Wide-field fundus image from infant ROP screening — 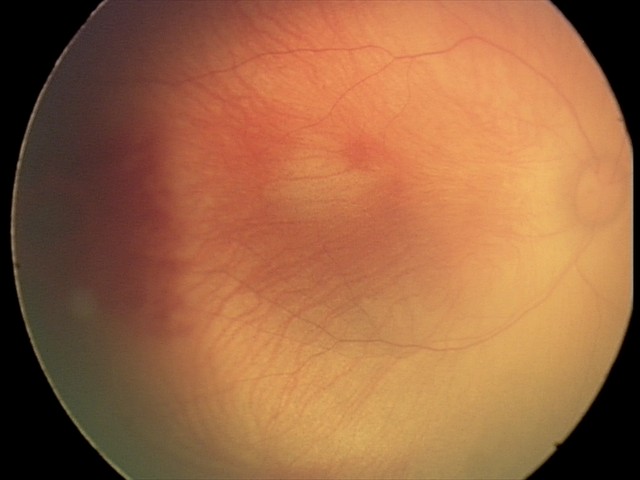 Screening examination consistent with retinal hemorrhages.